Color fundus image — 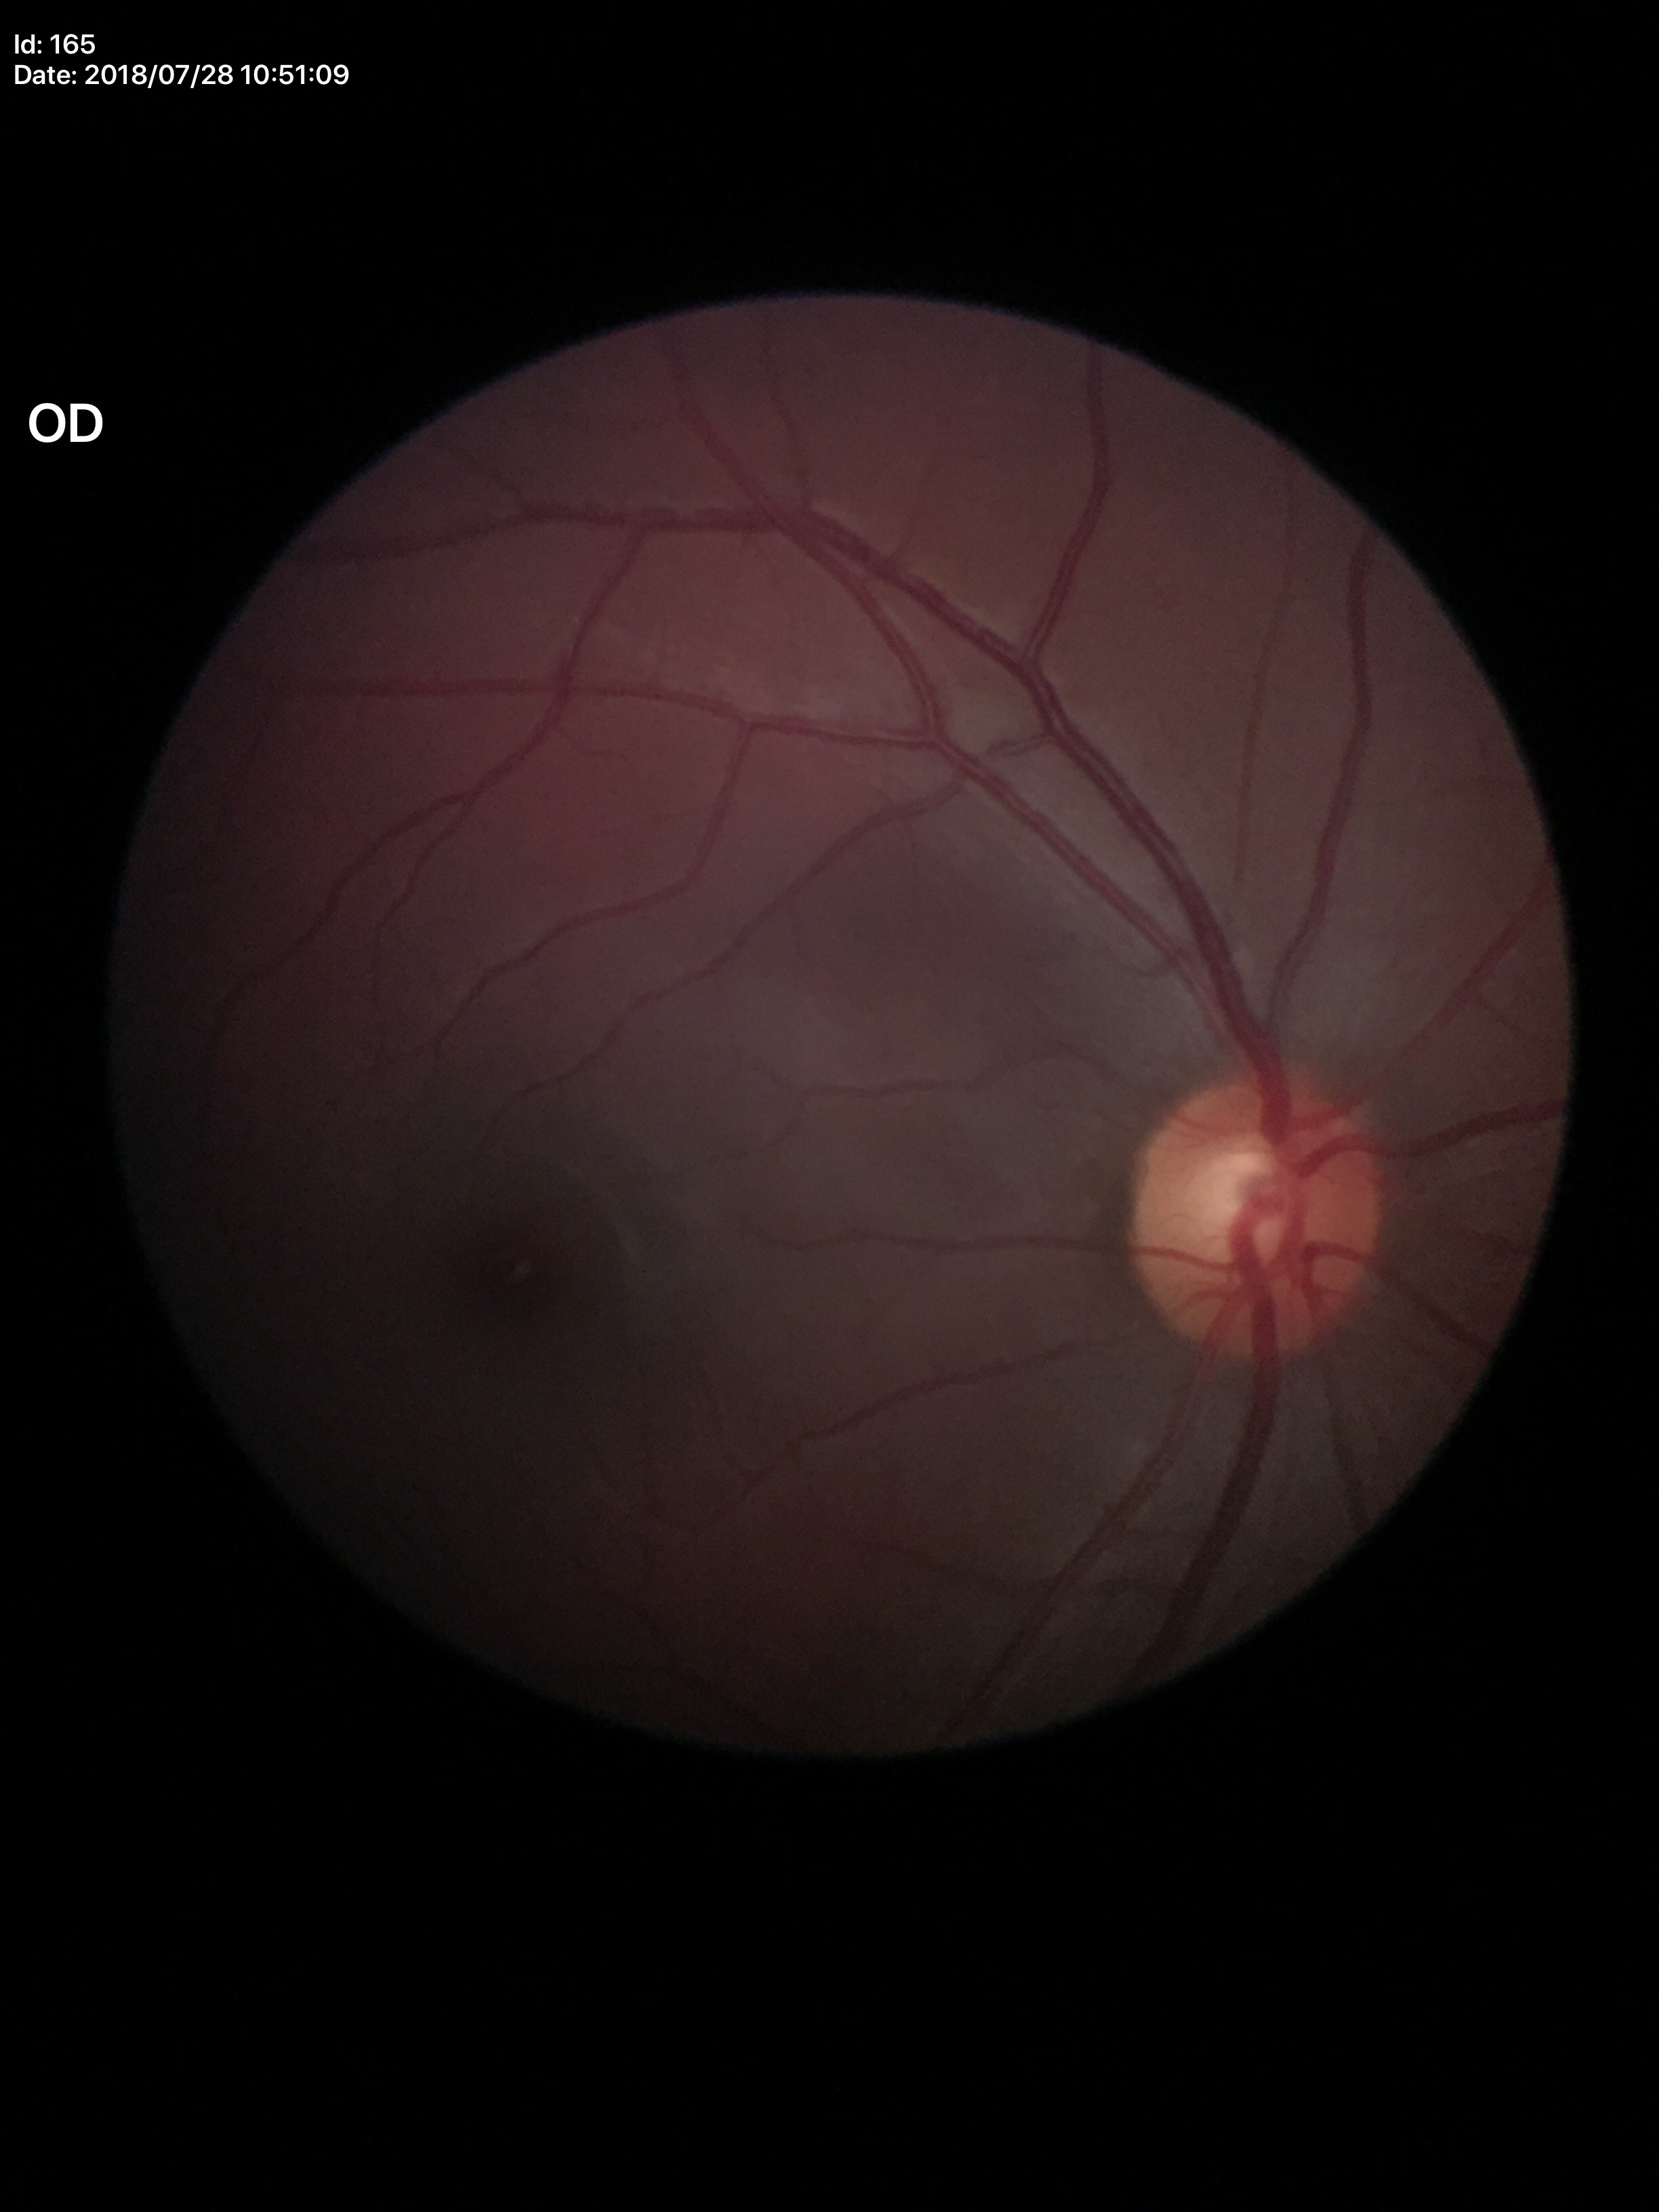 Glaucoma decision: negative (1/5 graders called glaucoma suspect); vertical C/D ratio: 0.53; horizontal CDR: 0.55